45-degree field of view — 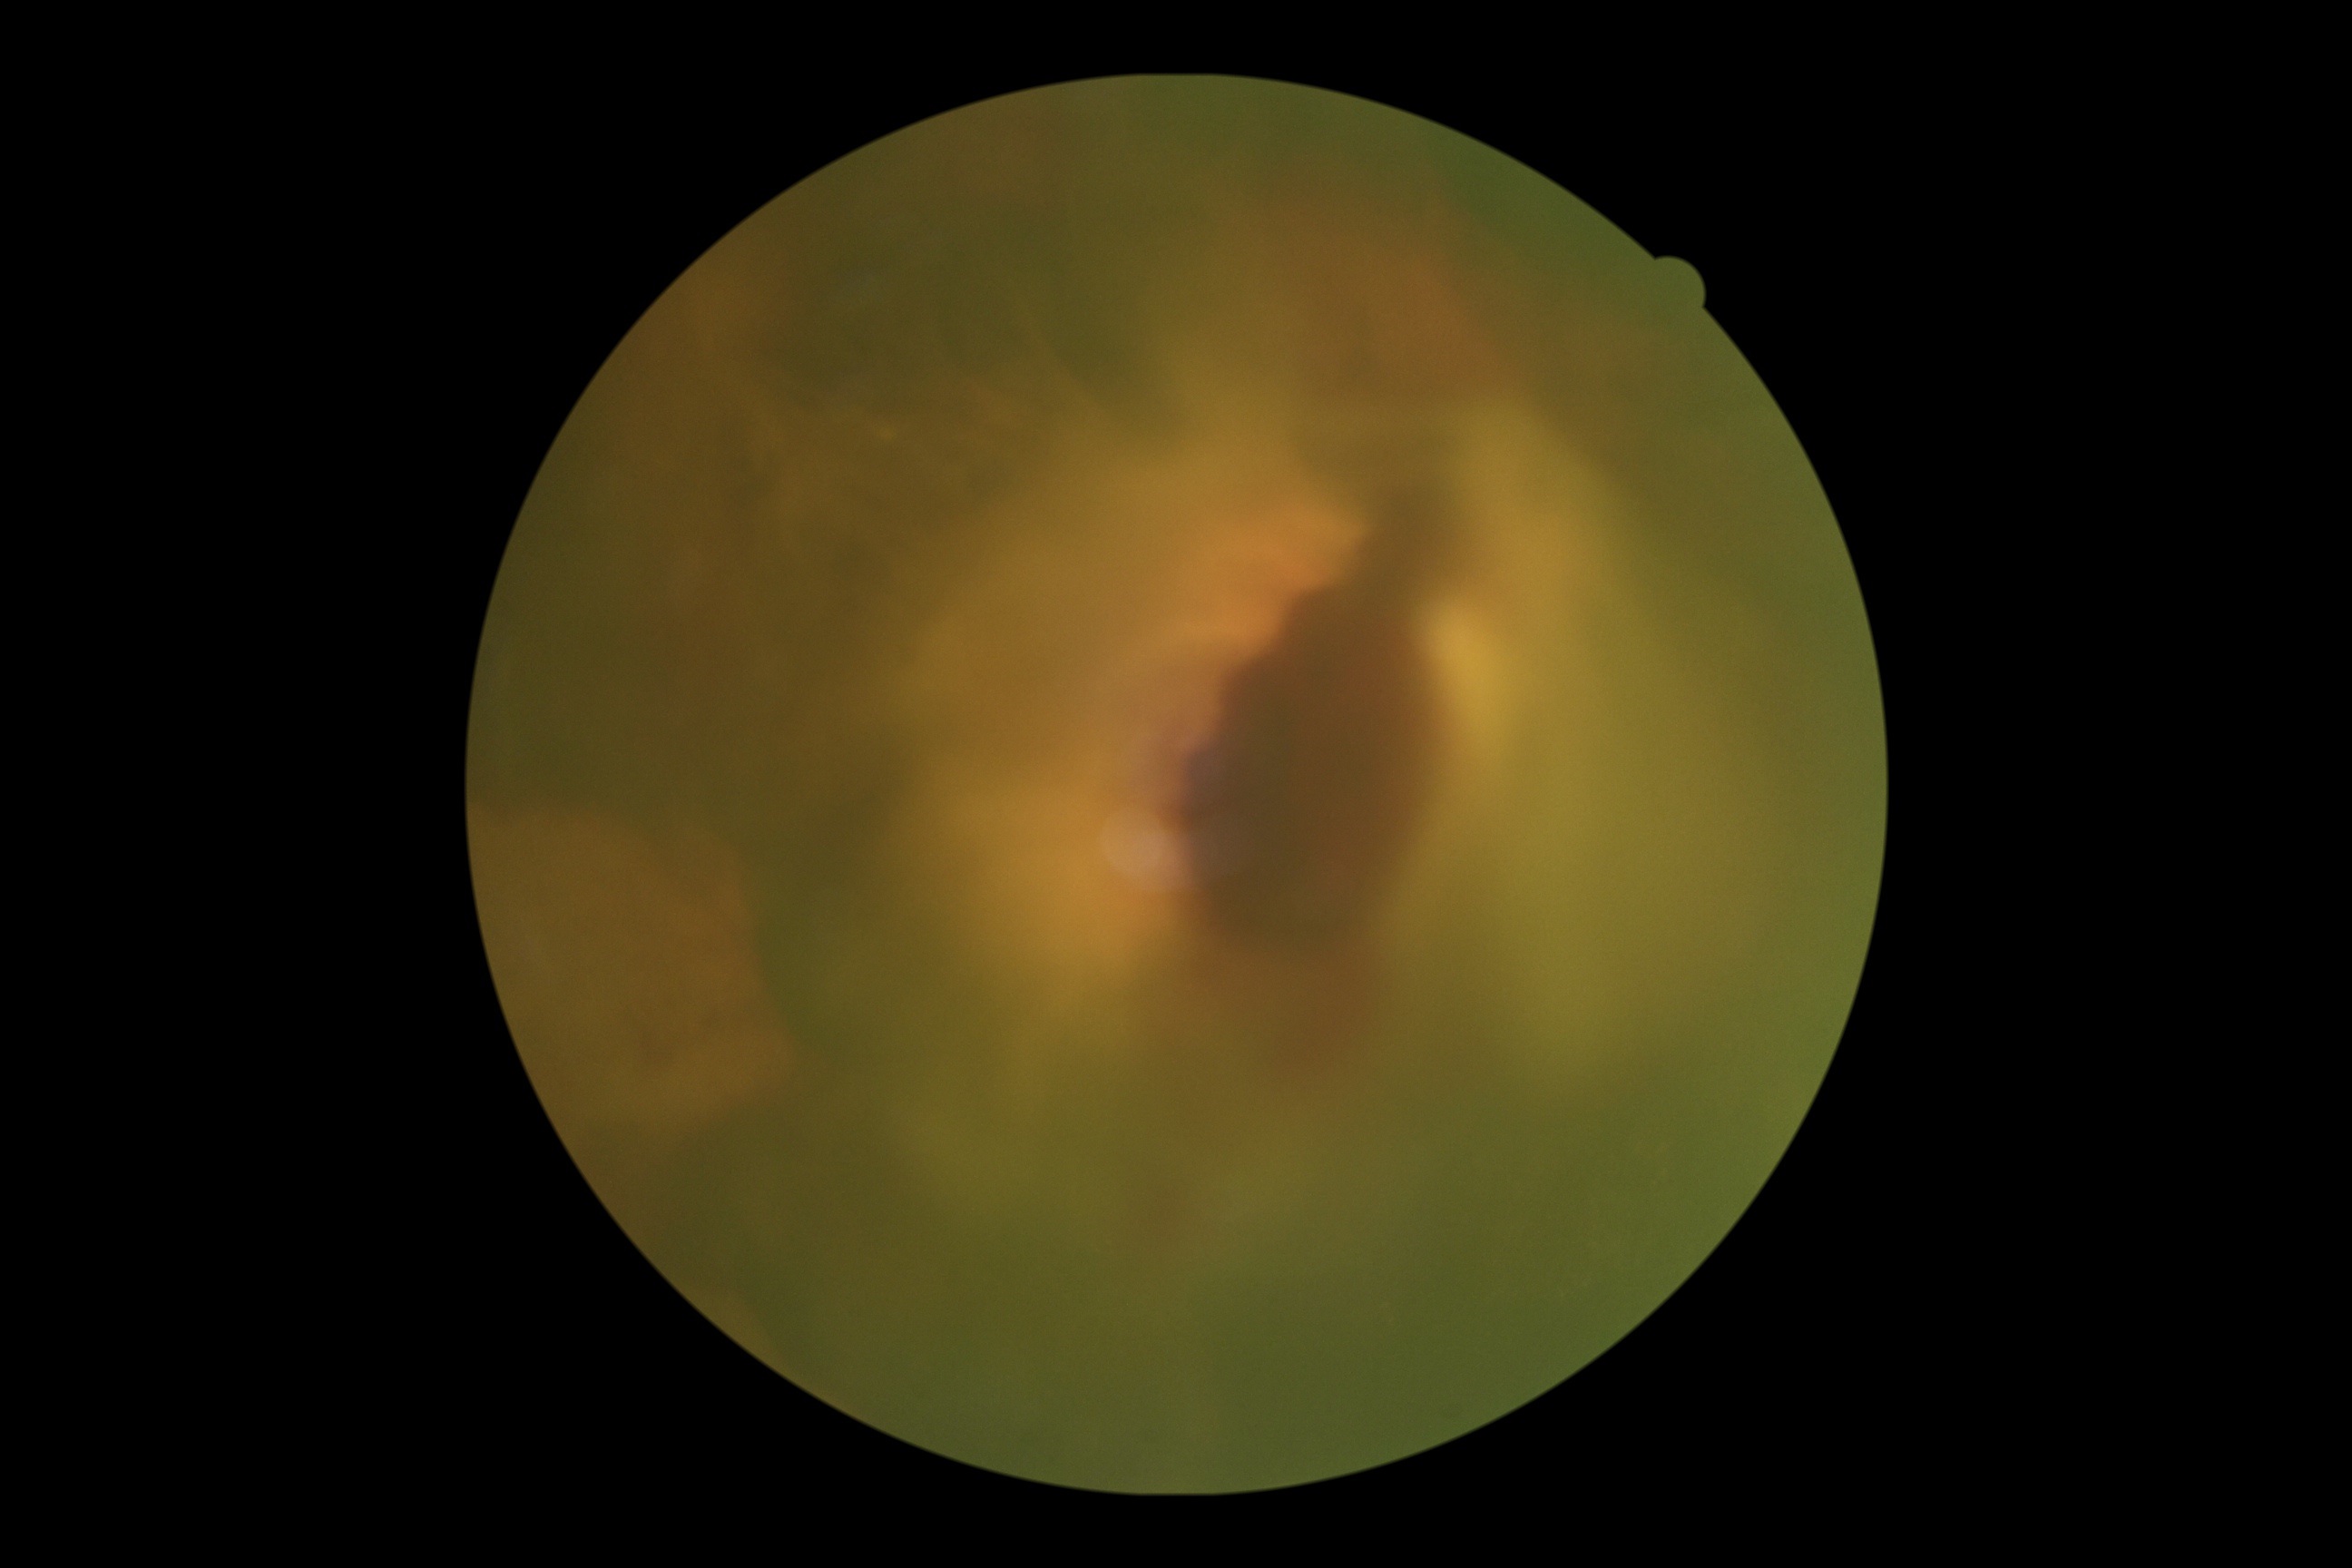
Diabetic retinopathy is grade 4 (PDR). DR class: proliferative diabetic retinopathy.